Image size 2102x1736: 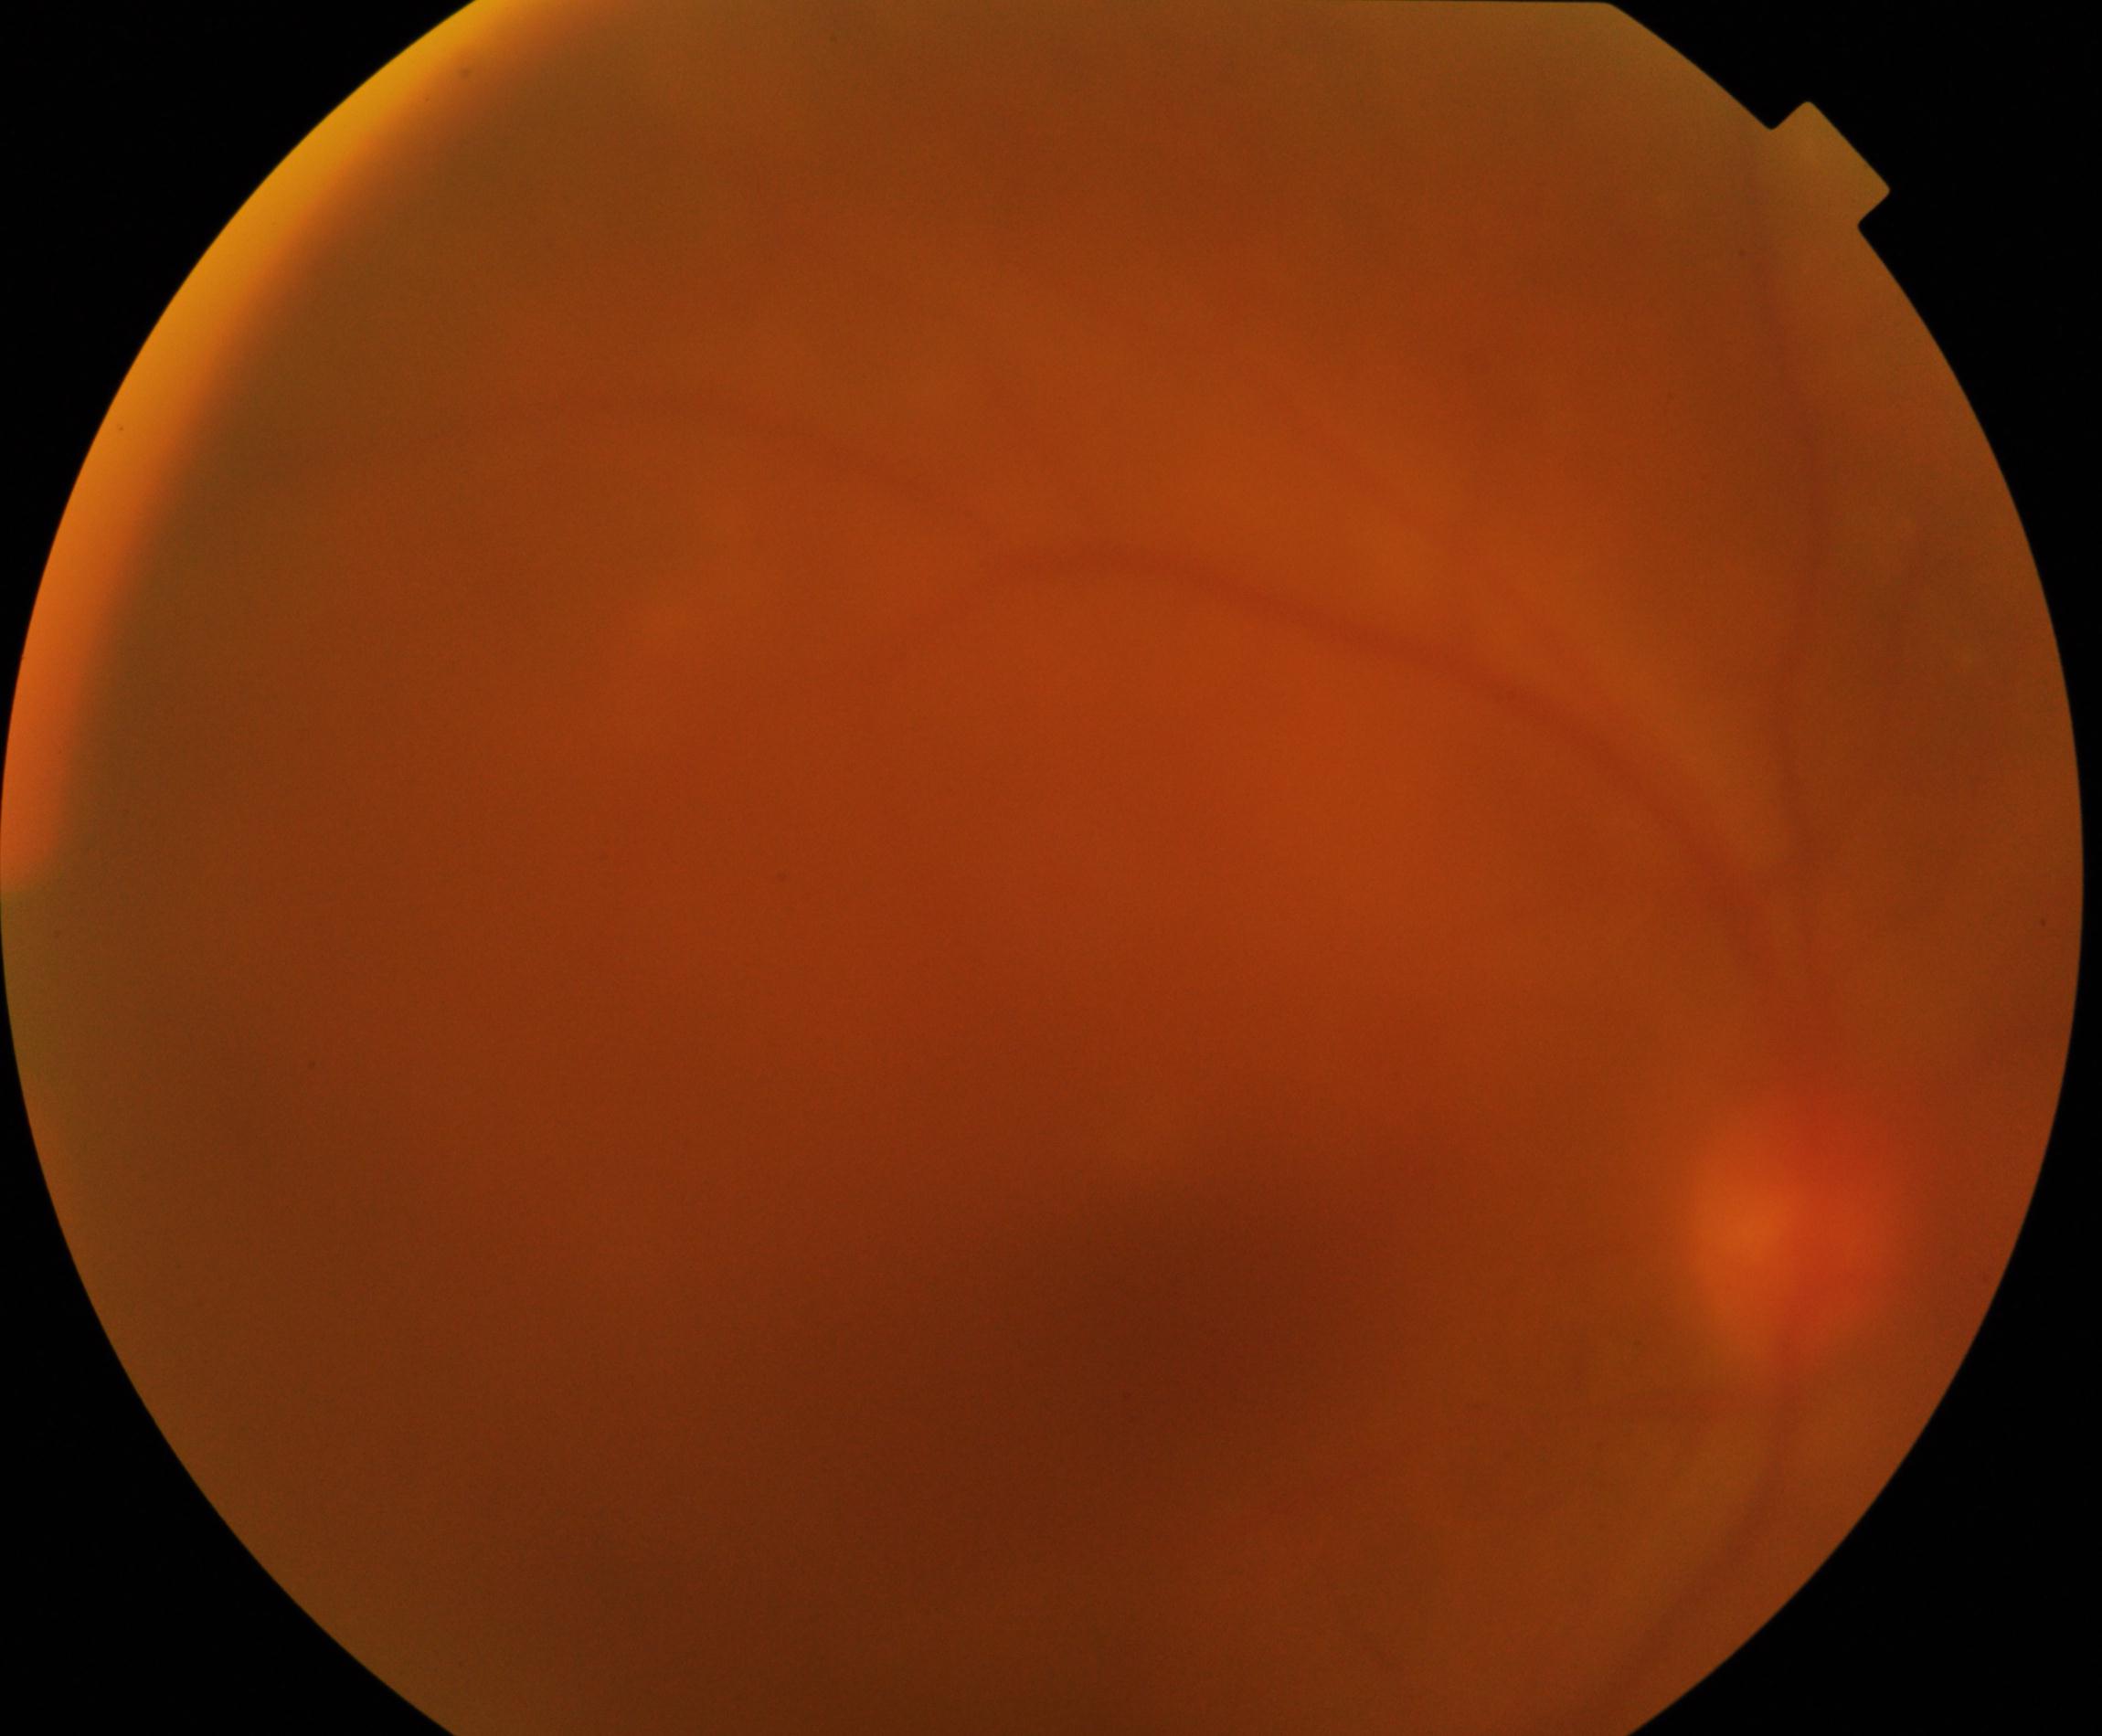

Quality: poor. Proliferative retinopathy: not identified.